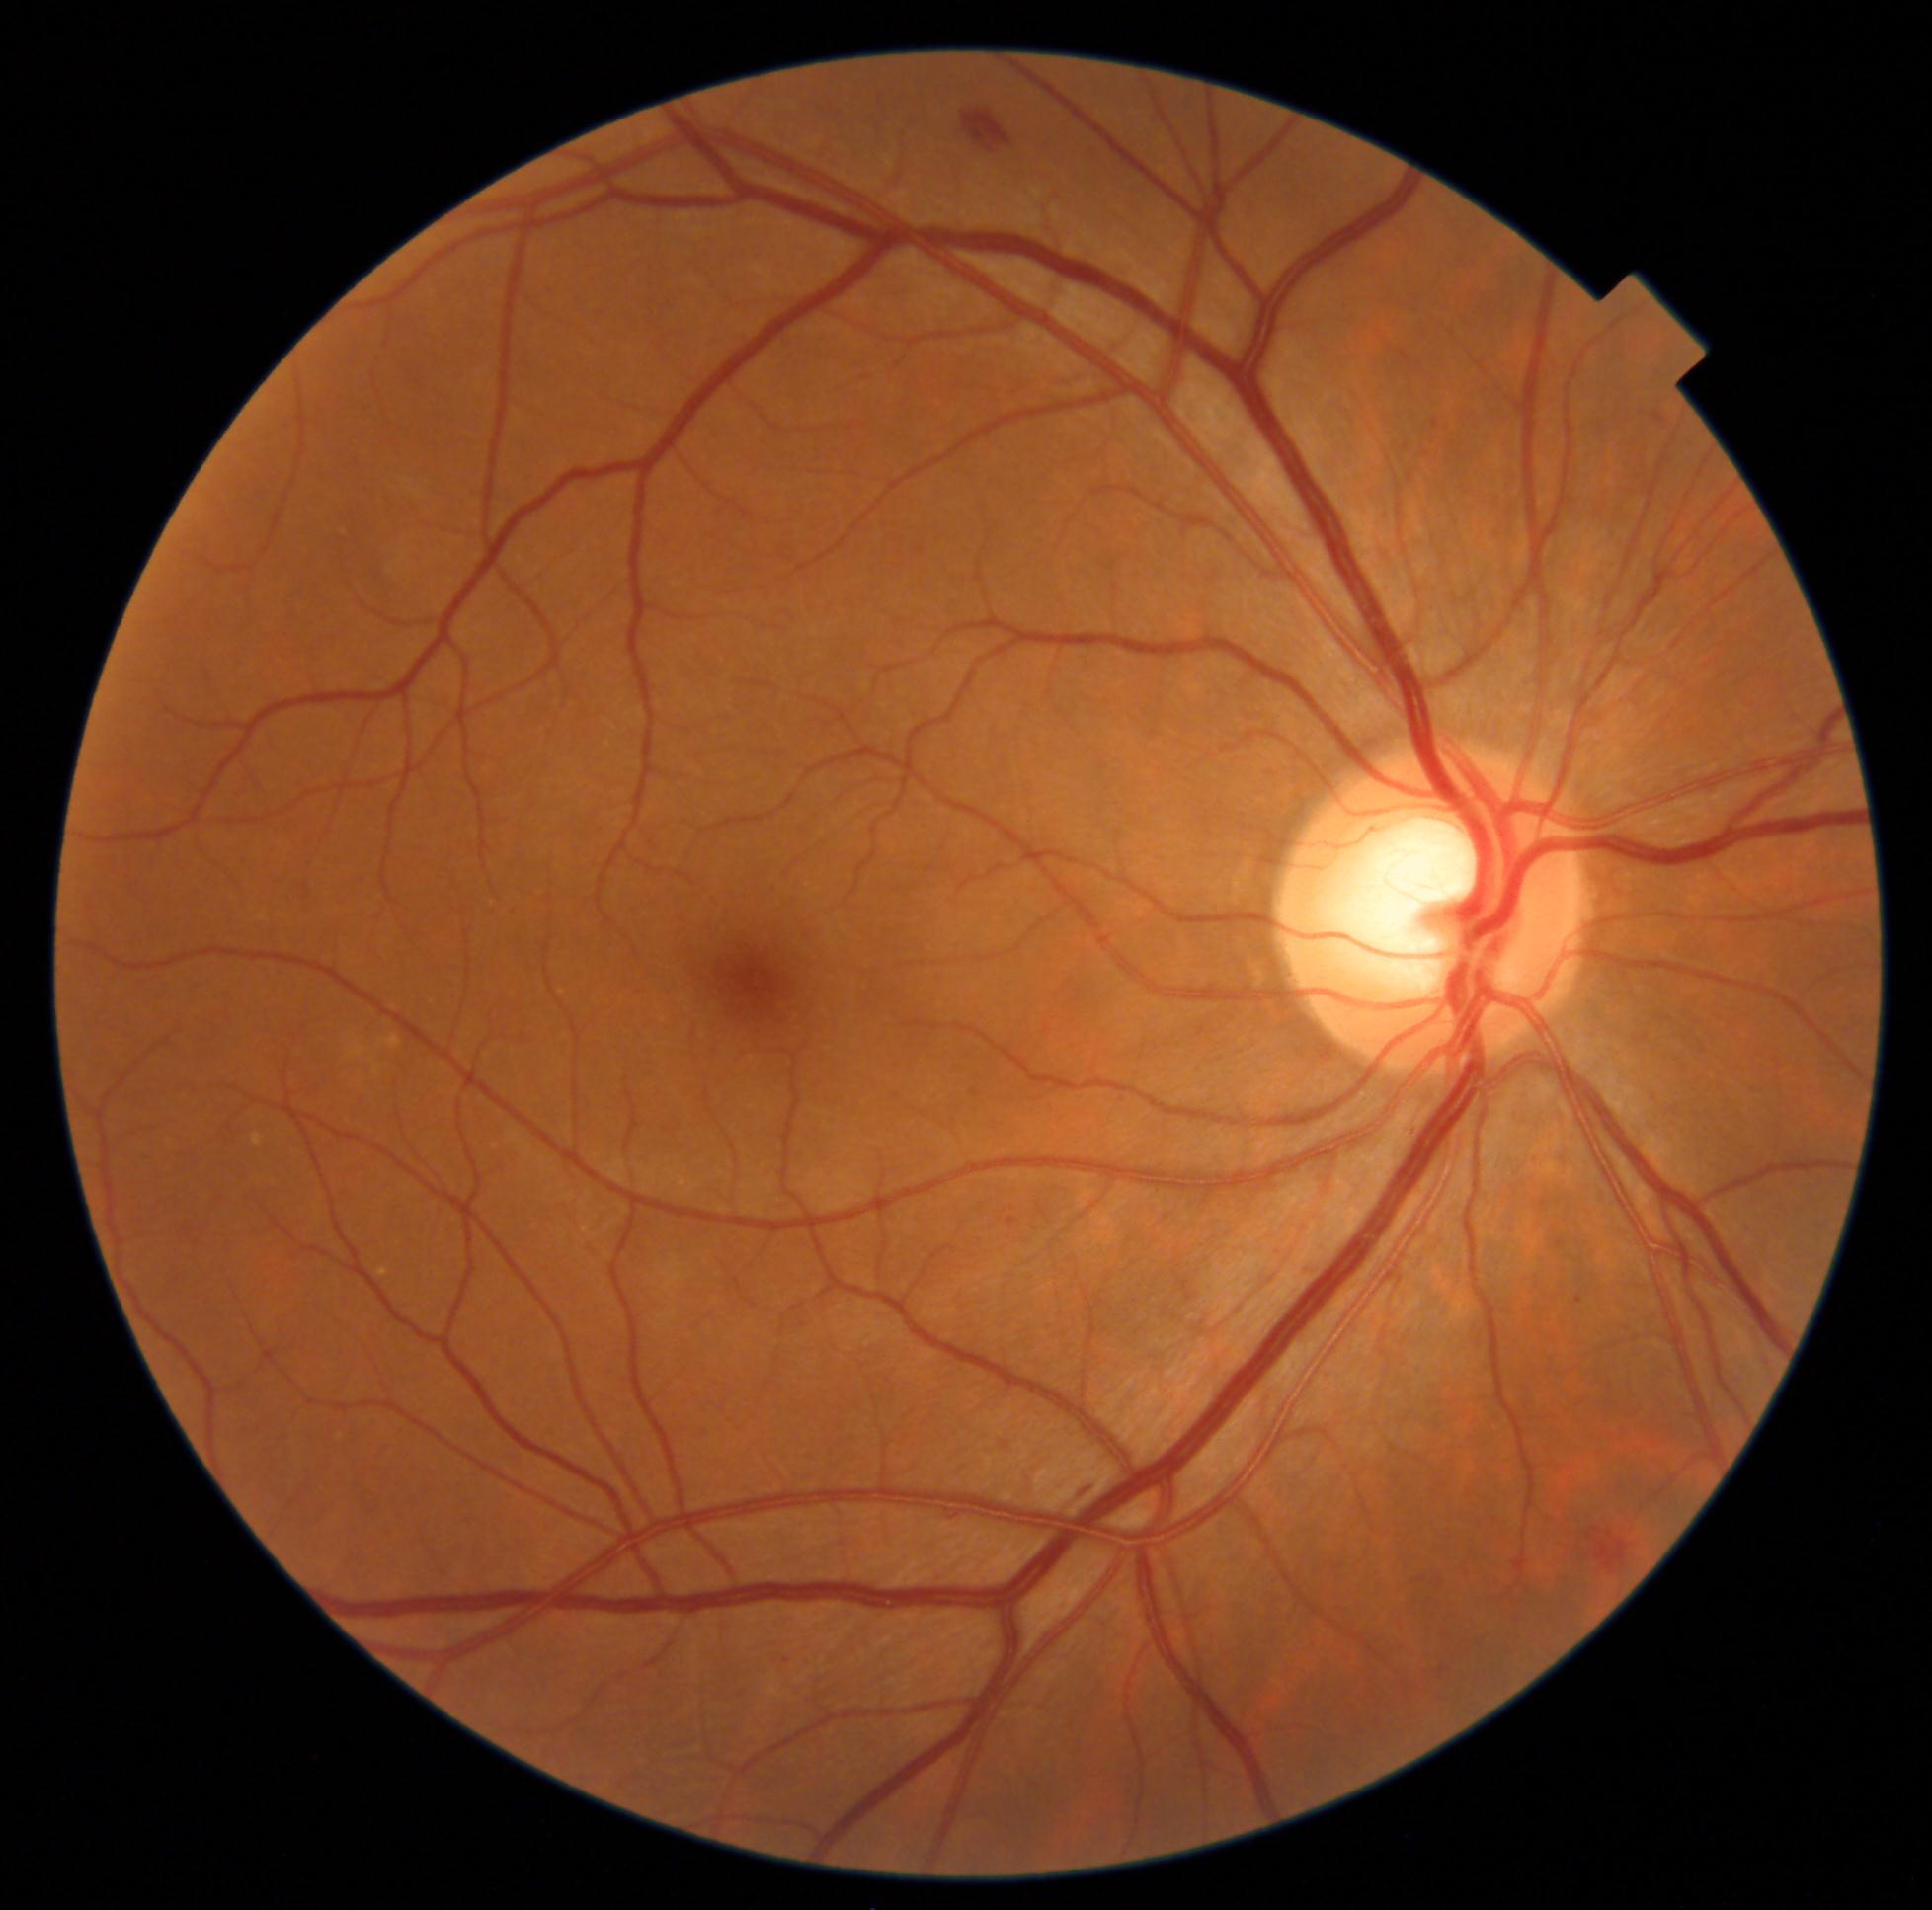 diabetic retinopathy severity: grade 2.